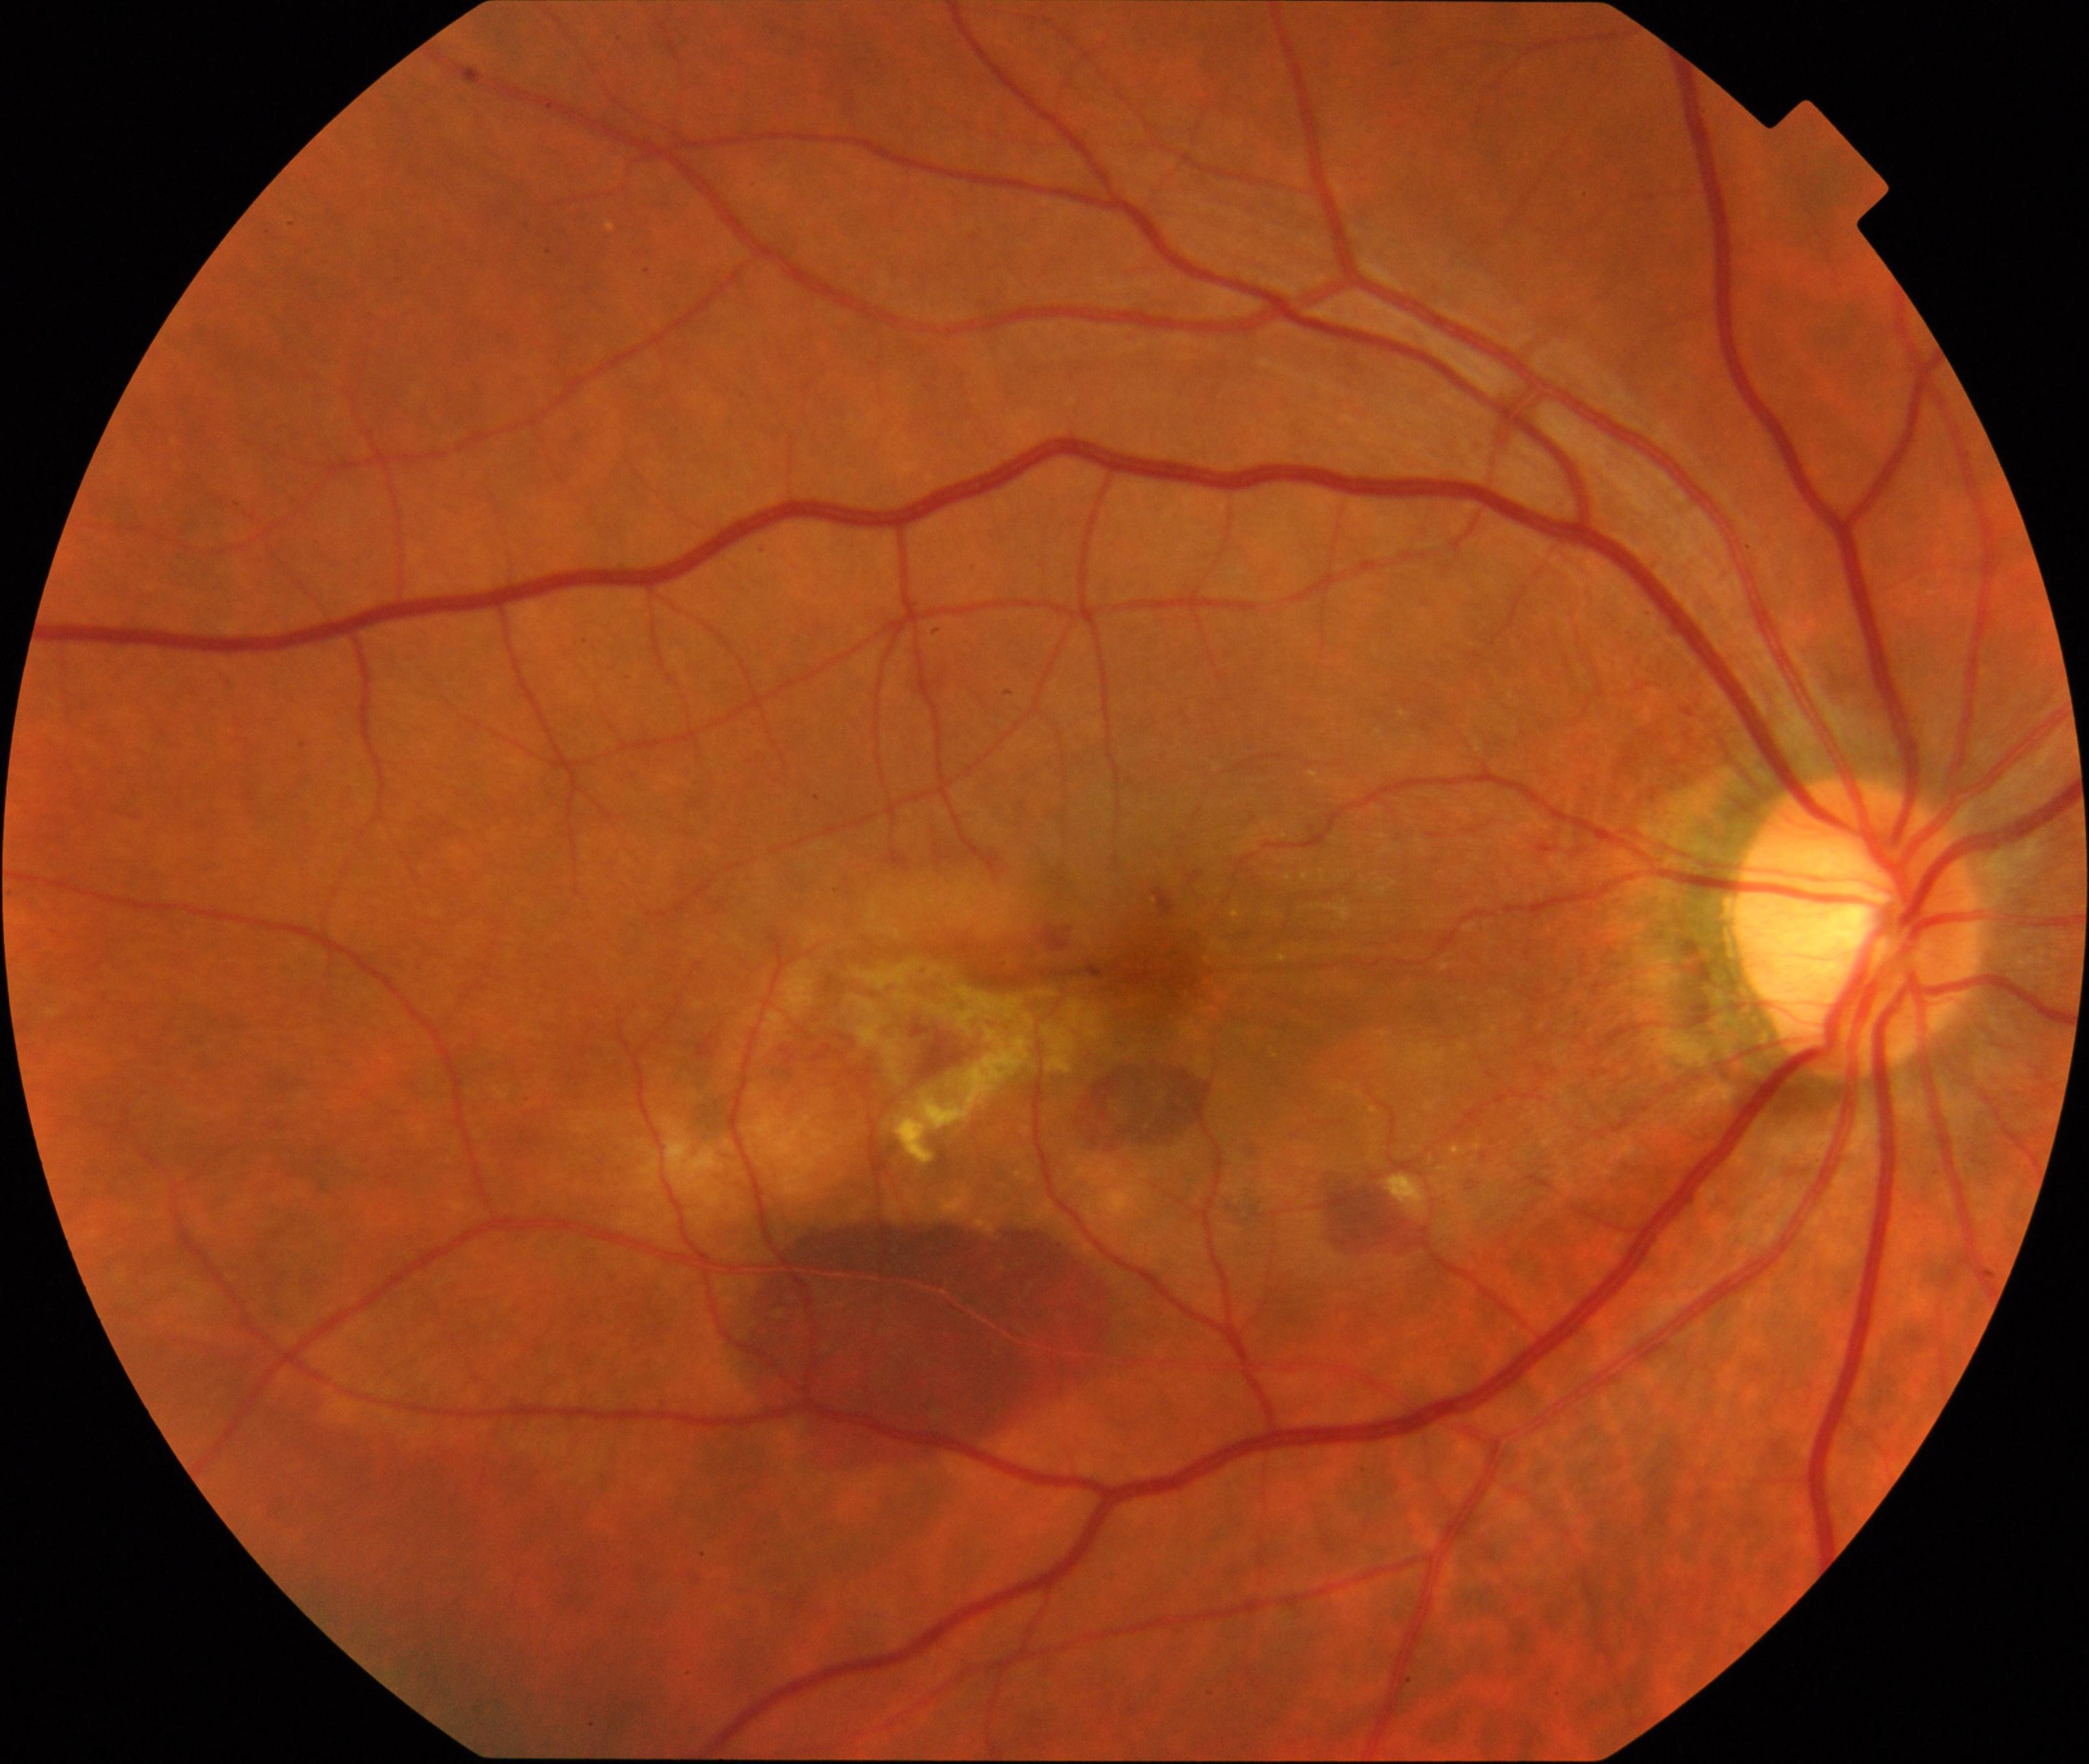 Classification: maculopathy.